NIDEK AFC-230 fundus camera: 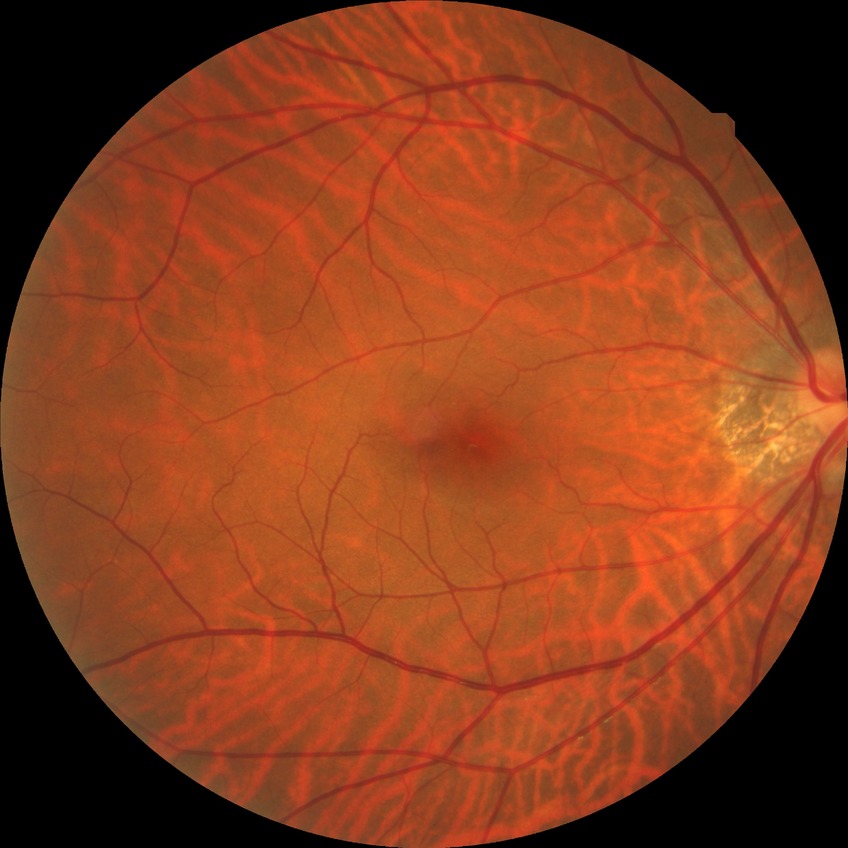 Diabetic retinopathy grade is no diabetic retinopathy.